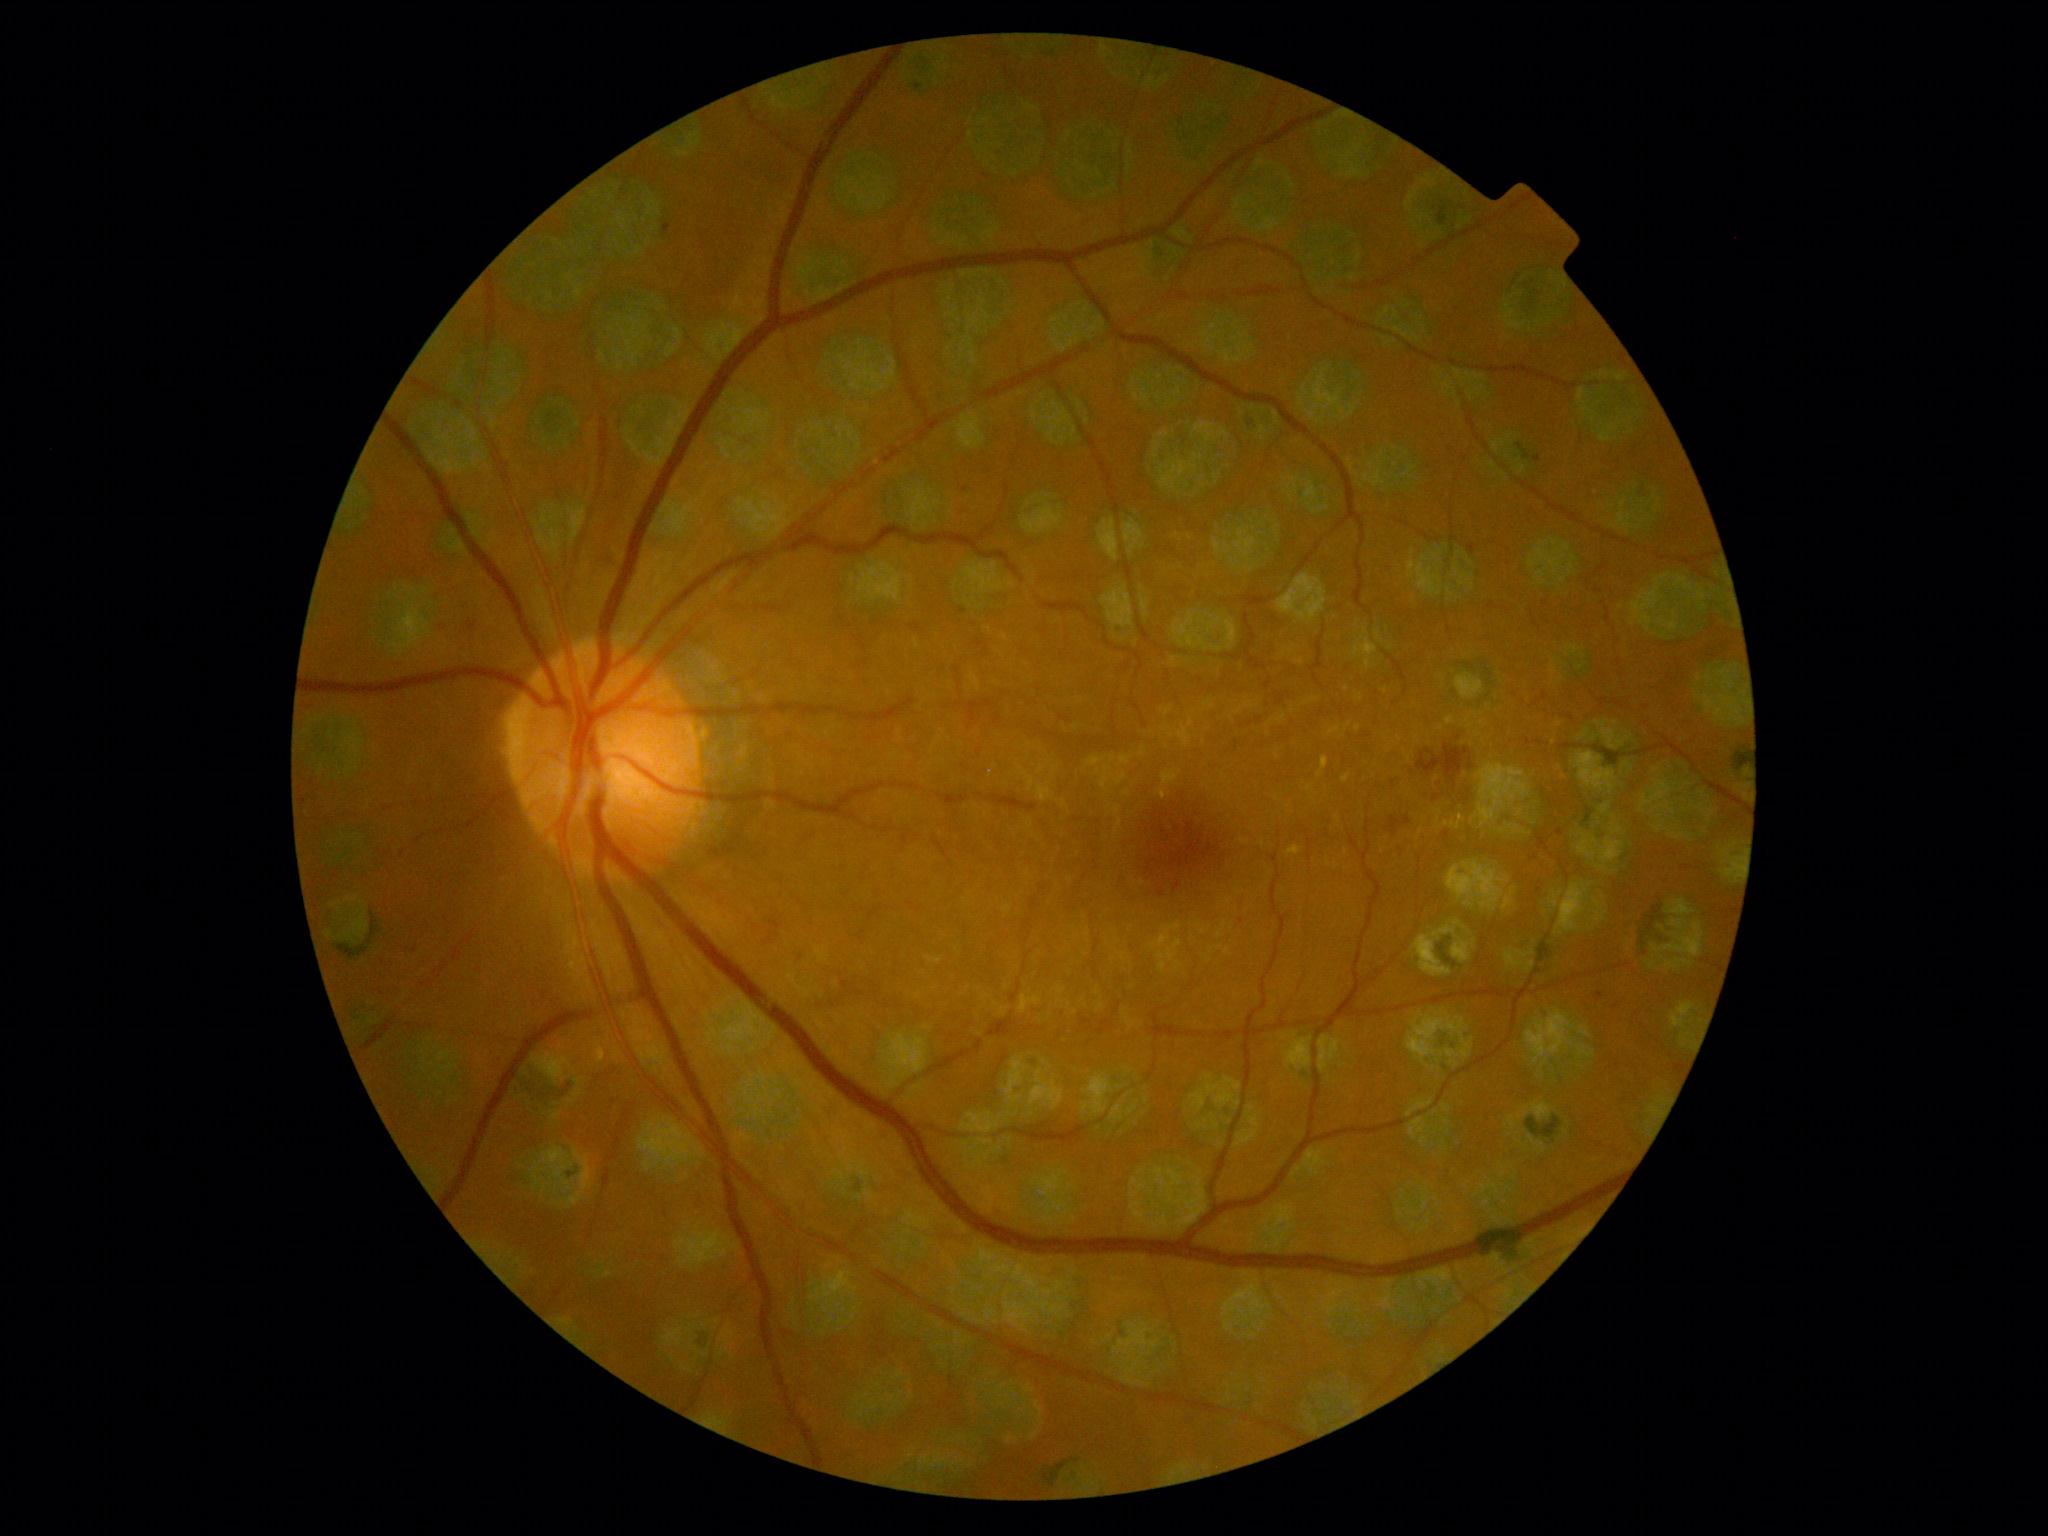

Diabetic retinopathy (DR) is 2.